1920 by 1440 pixels:
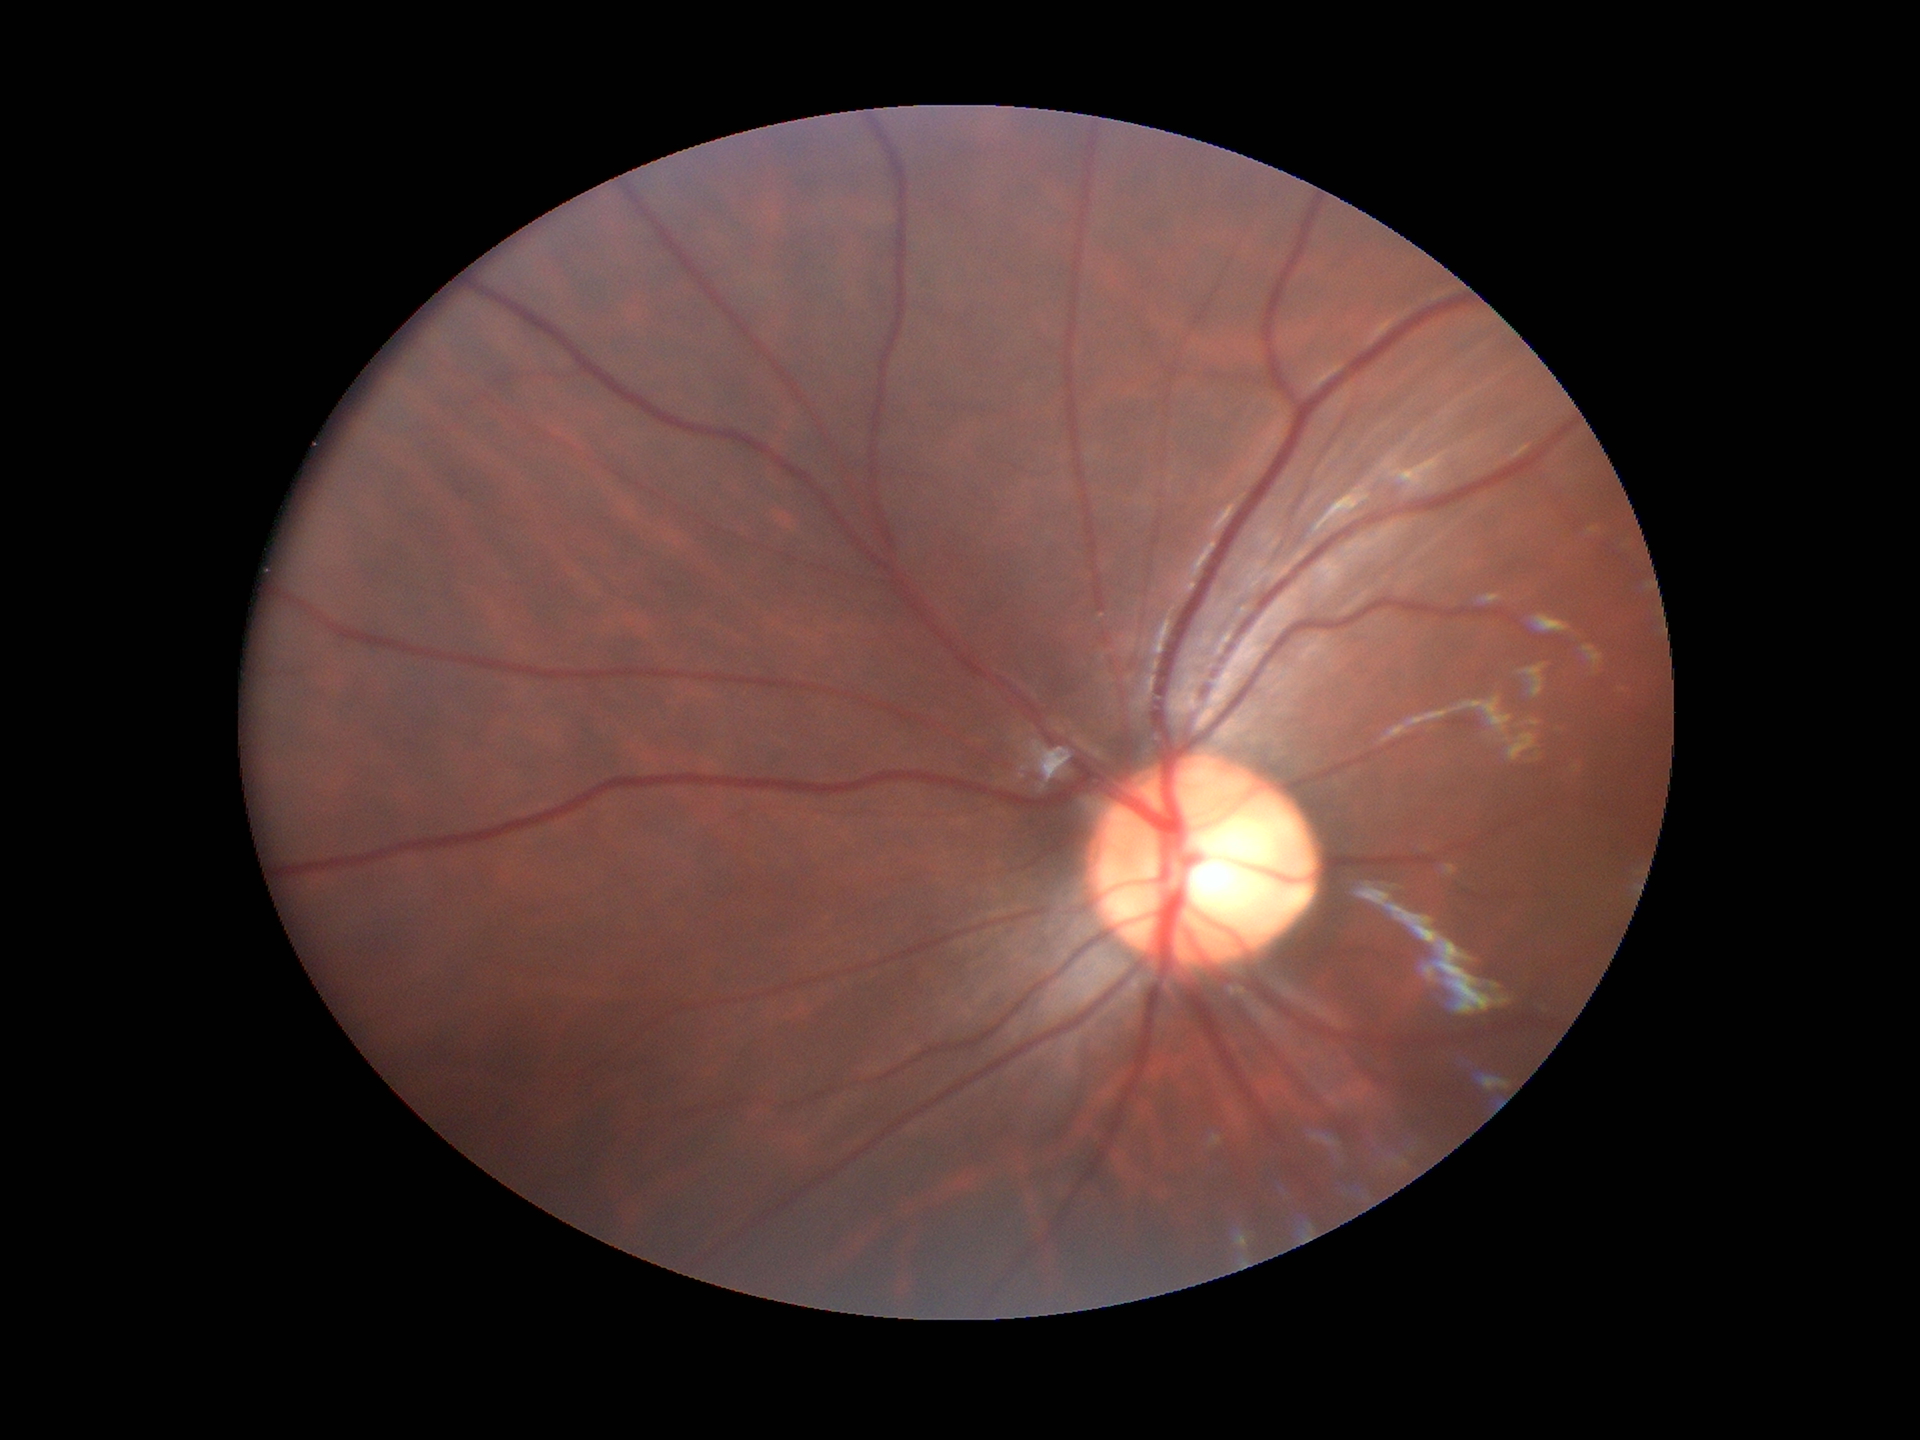 Glaucoma screening impression: no suspicious findings.
Vertical CDR (VCDR) is 0.56.
Horizontal CDR (HCDR): 0.55.